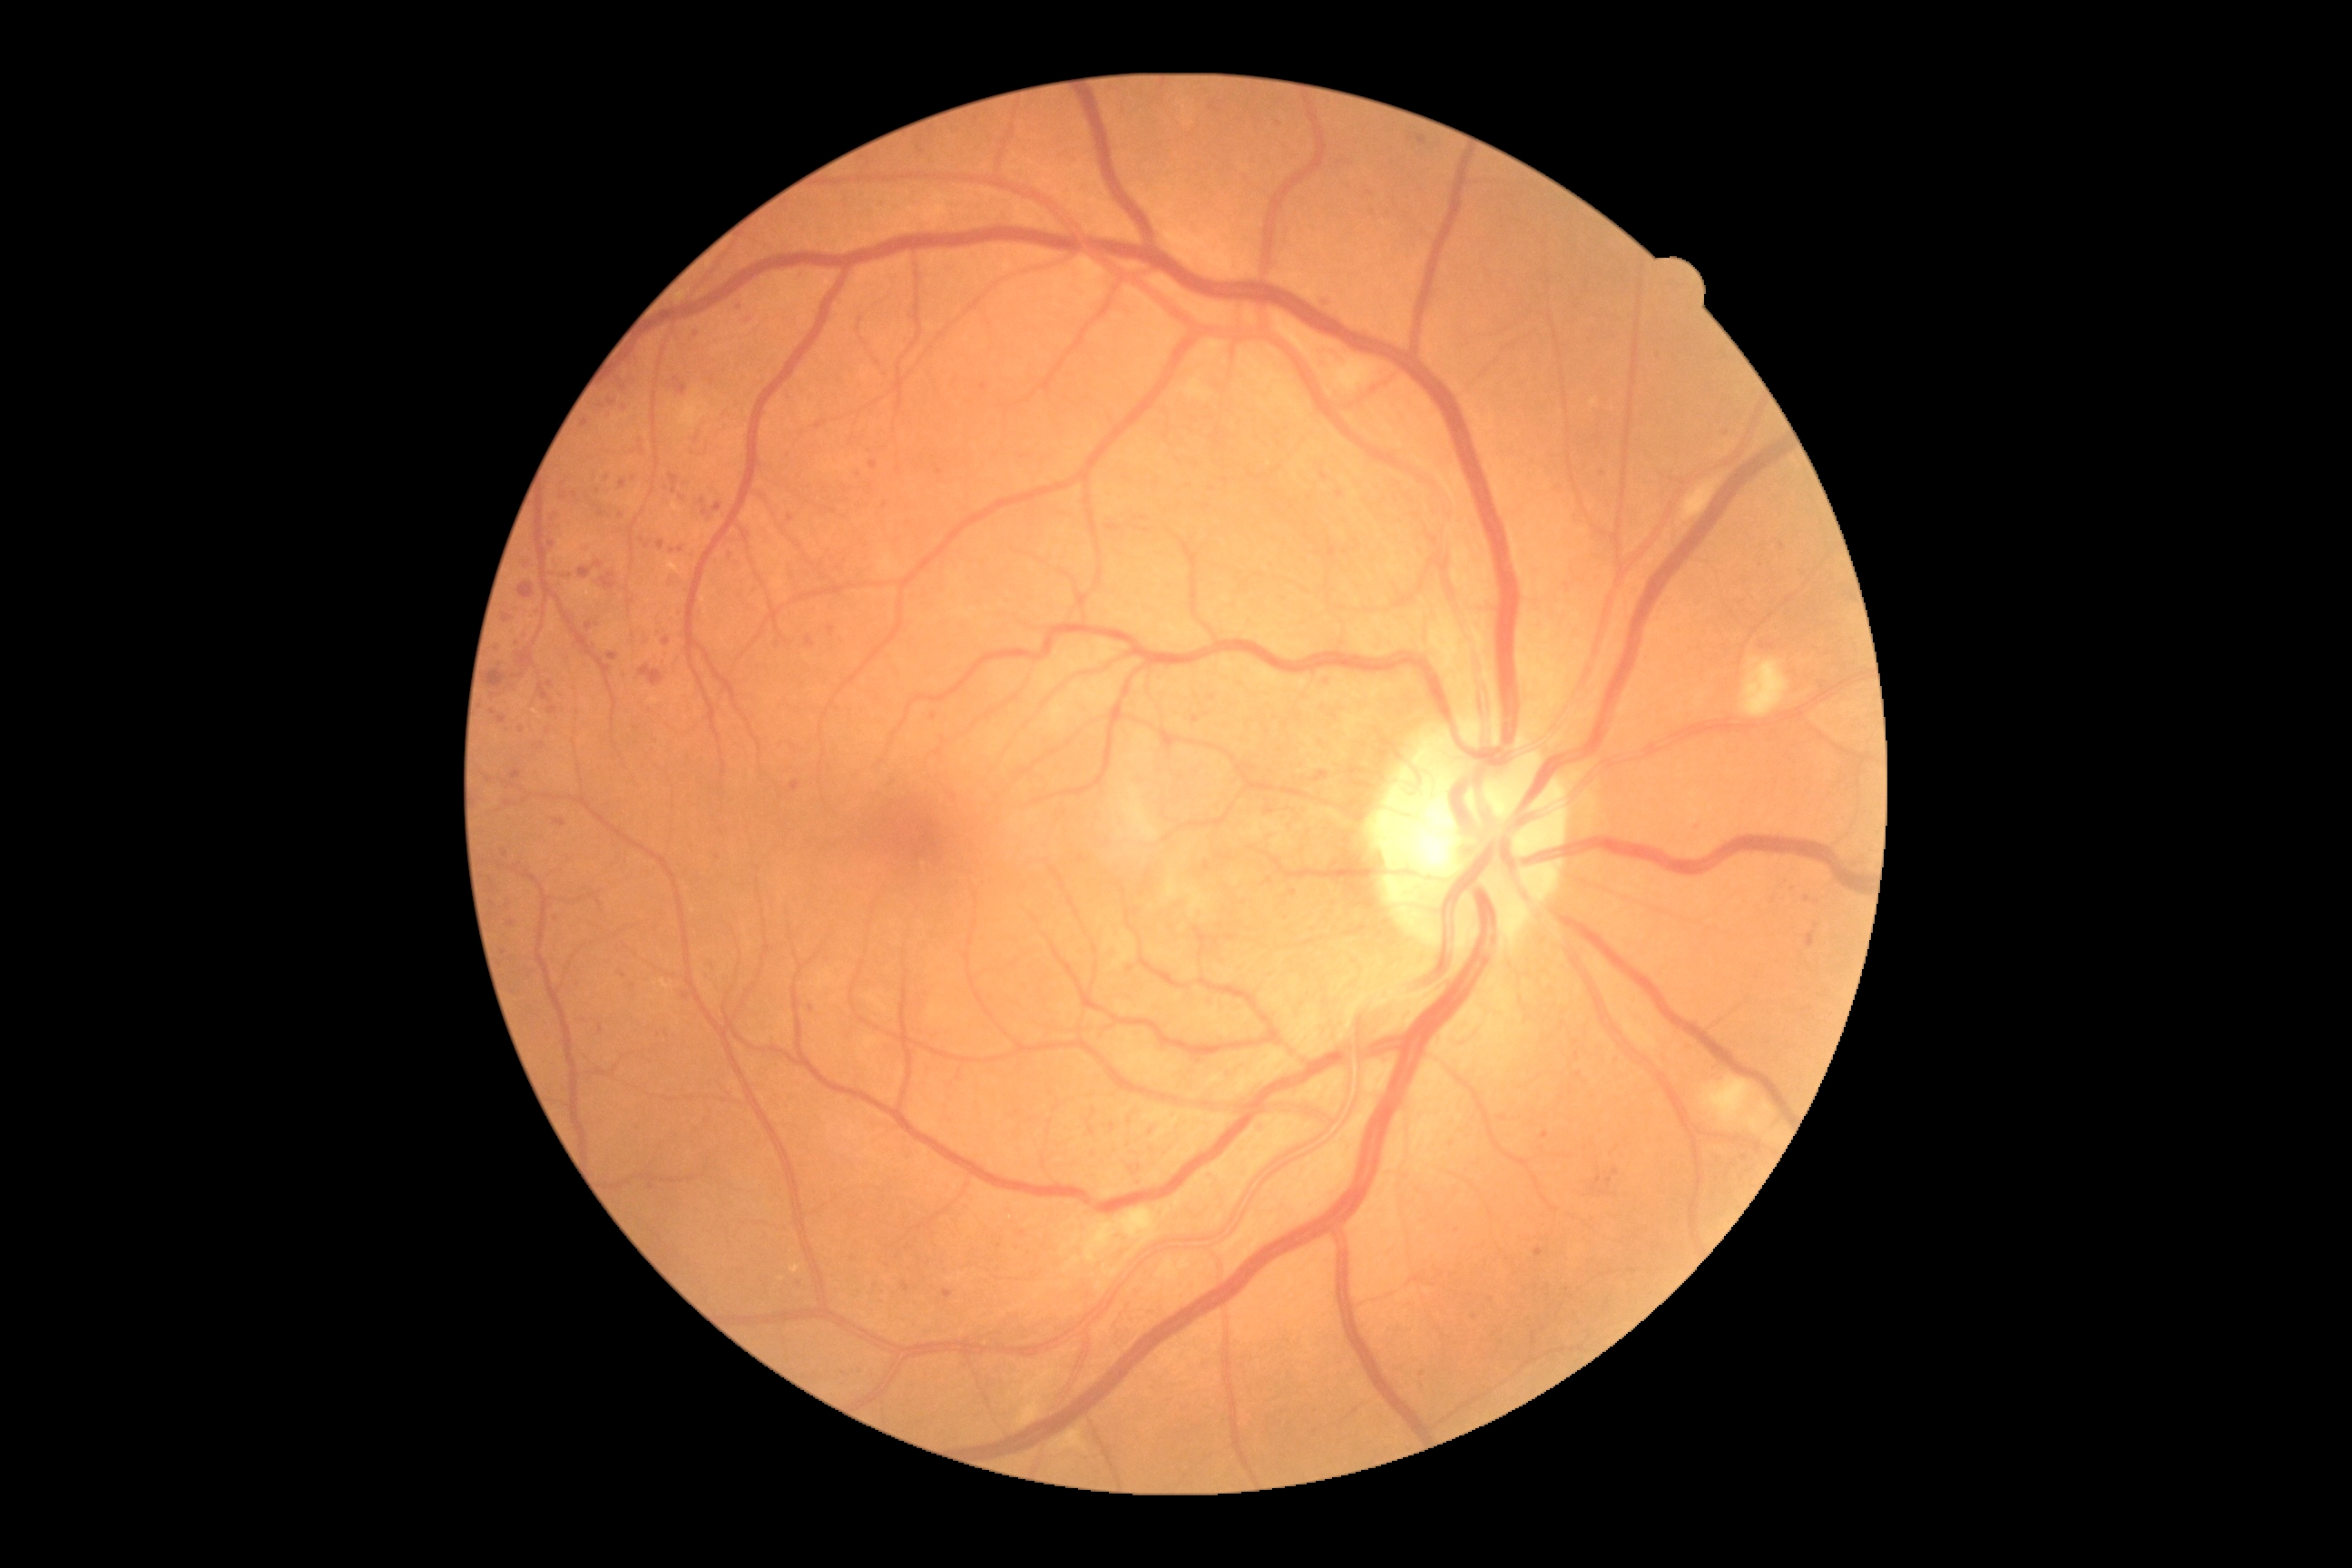 {"partial":true,"dr_grade":2,"lesions":{"ma":[[607,652,618,662],[683,994,691,999],[1612,1170,1620,1177],[1326,676,1331,685],[903,1282,910,1291],[556,692,564,698],[549,516,558,525]],"ma_small":[[705,512],[1776,902],[1001,1247],[625,409],[601,512],[623,675],[1212,698],[1503,1119],[899,471],[499,648]]}}